Posterior pole photograph:
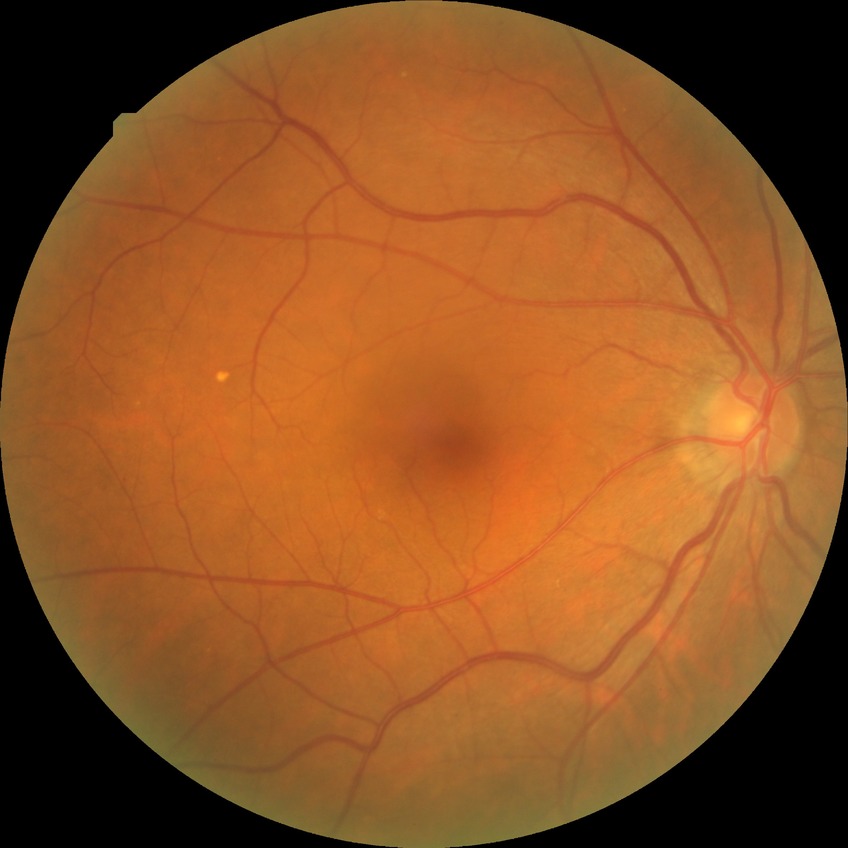

DR class@non-proliferative diabetic retinopathy, DR severity@SDR.